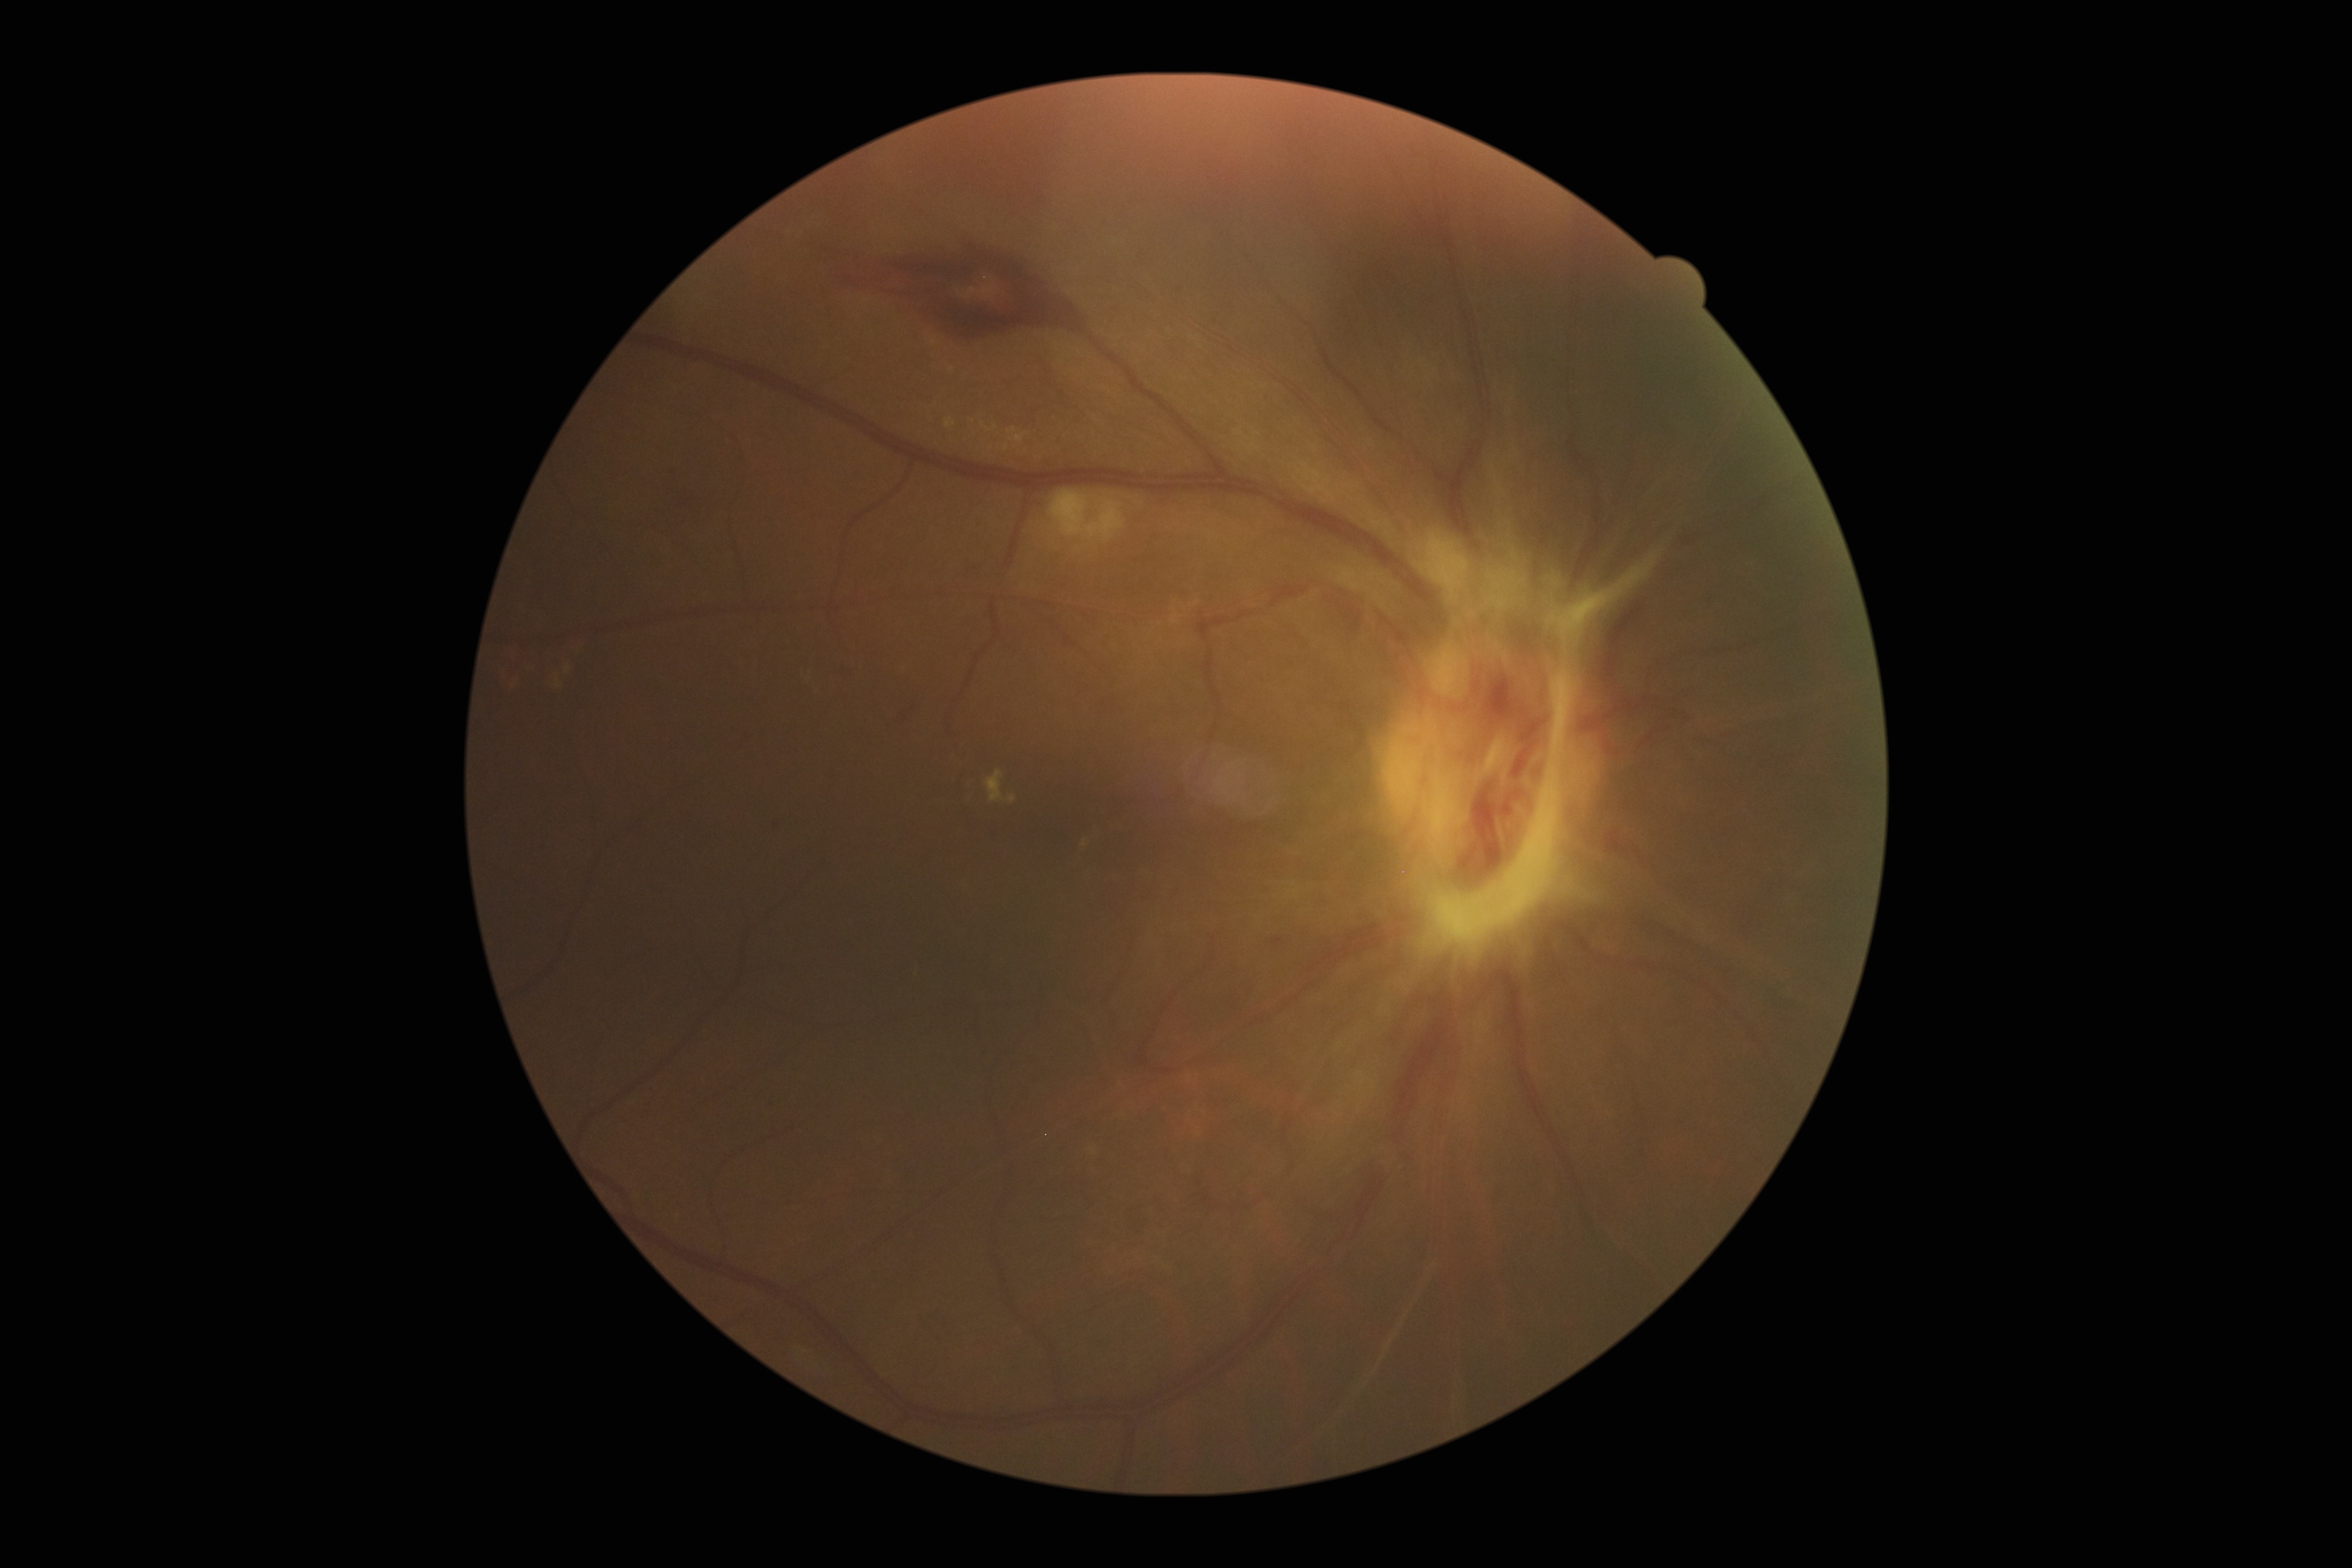
retinopathy = grade 4 (PDR) — neovascularization and/or vitreous/pre-retinal hemorrhage.